Color fundus image.
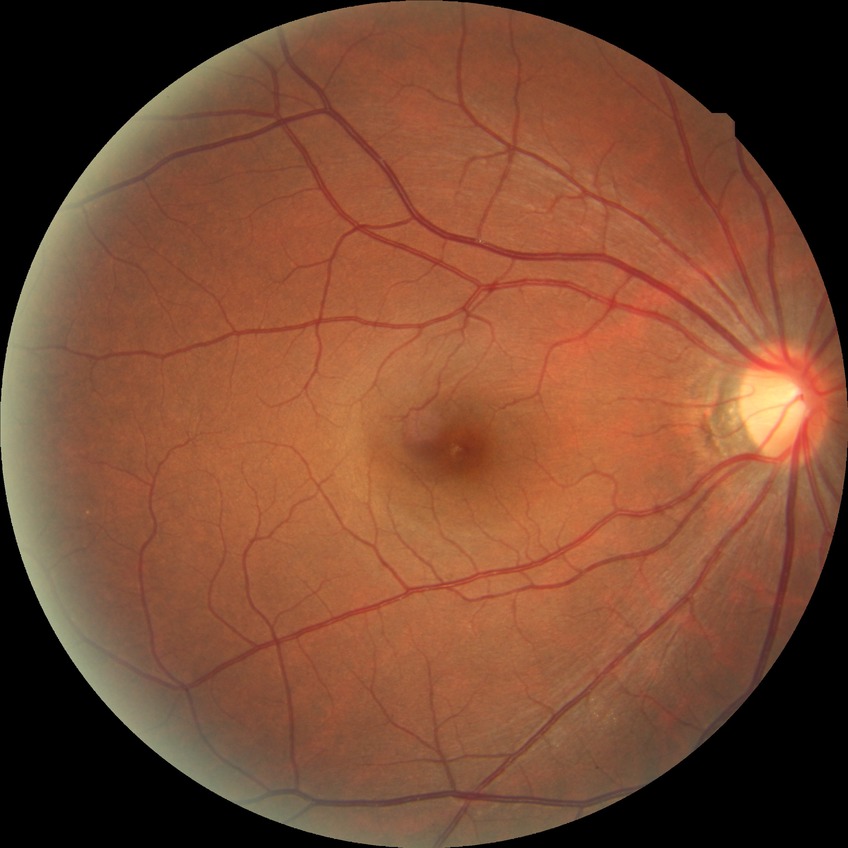
Diabetic retinopathy (DR): no diabetic retinopathy (NDR).